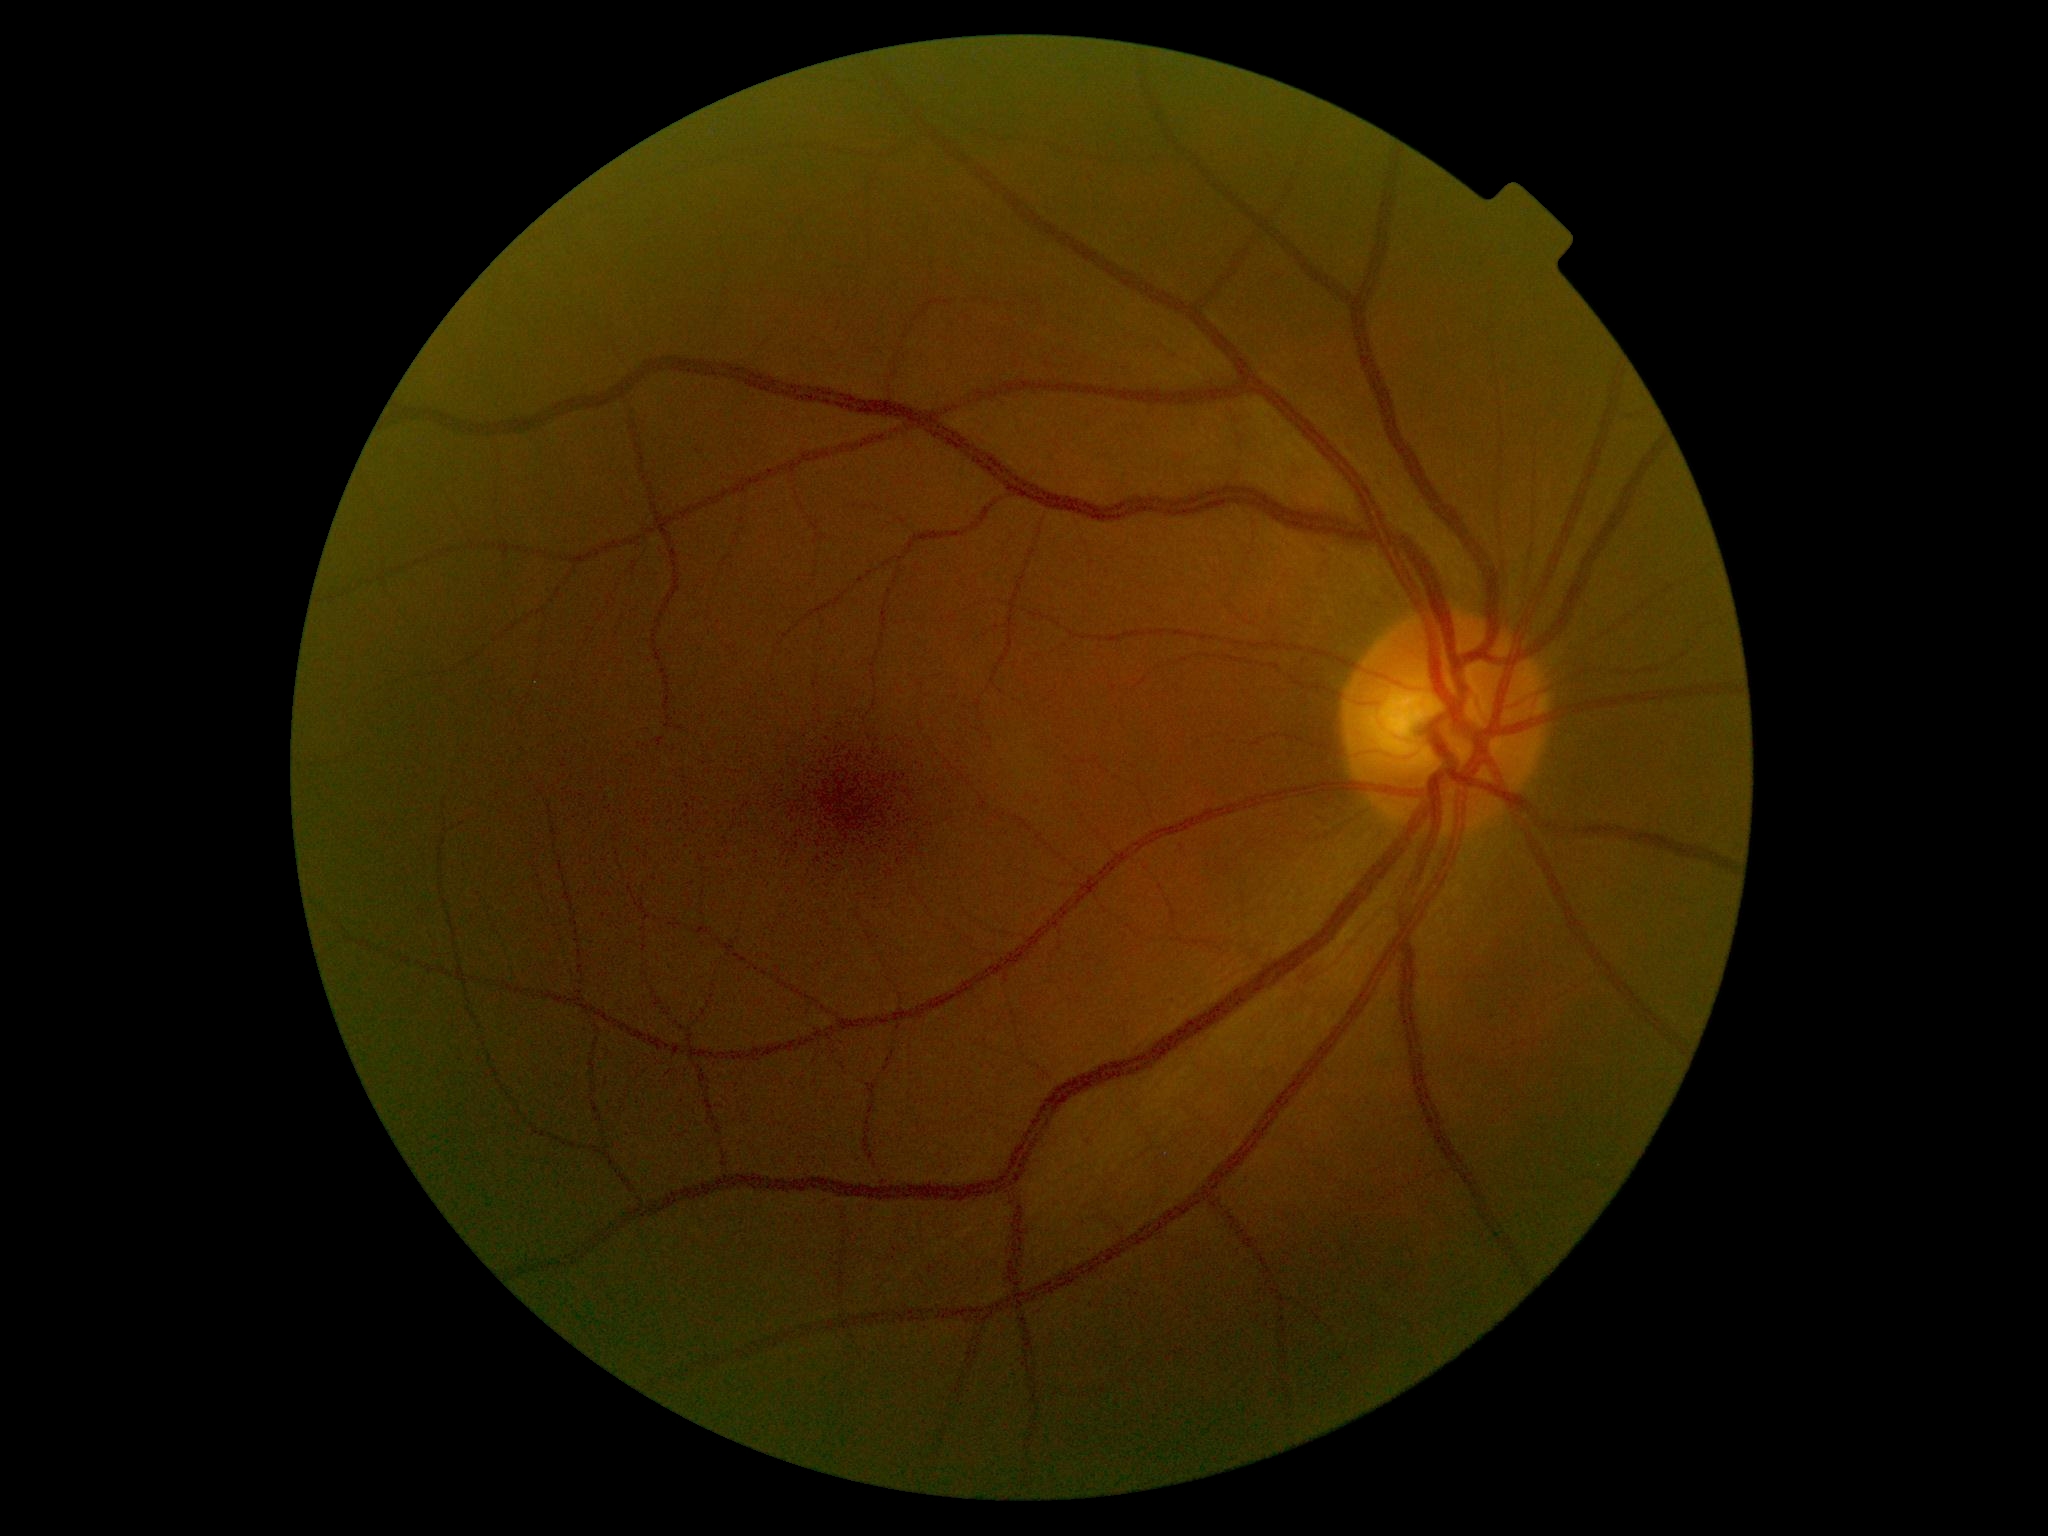 Diabetic retinopathy (DR): 0/4.